848 by 848 pixels. DR severity per modified Davis staging — 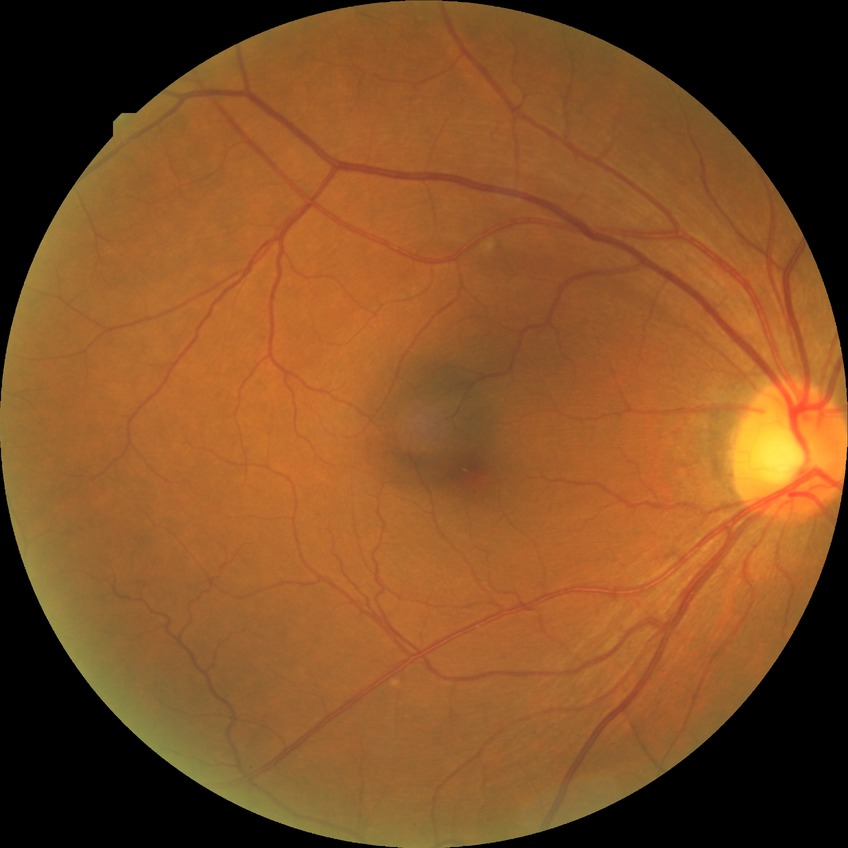 Modified Davis grade is NDR.